1960x1897px:
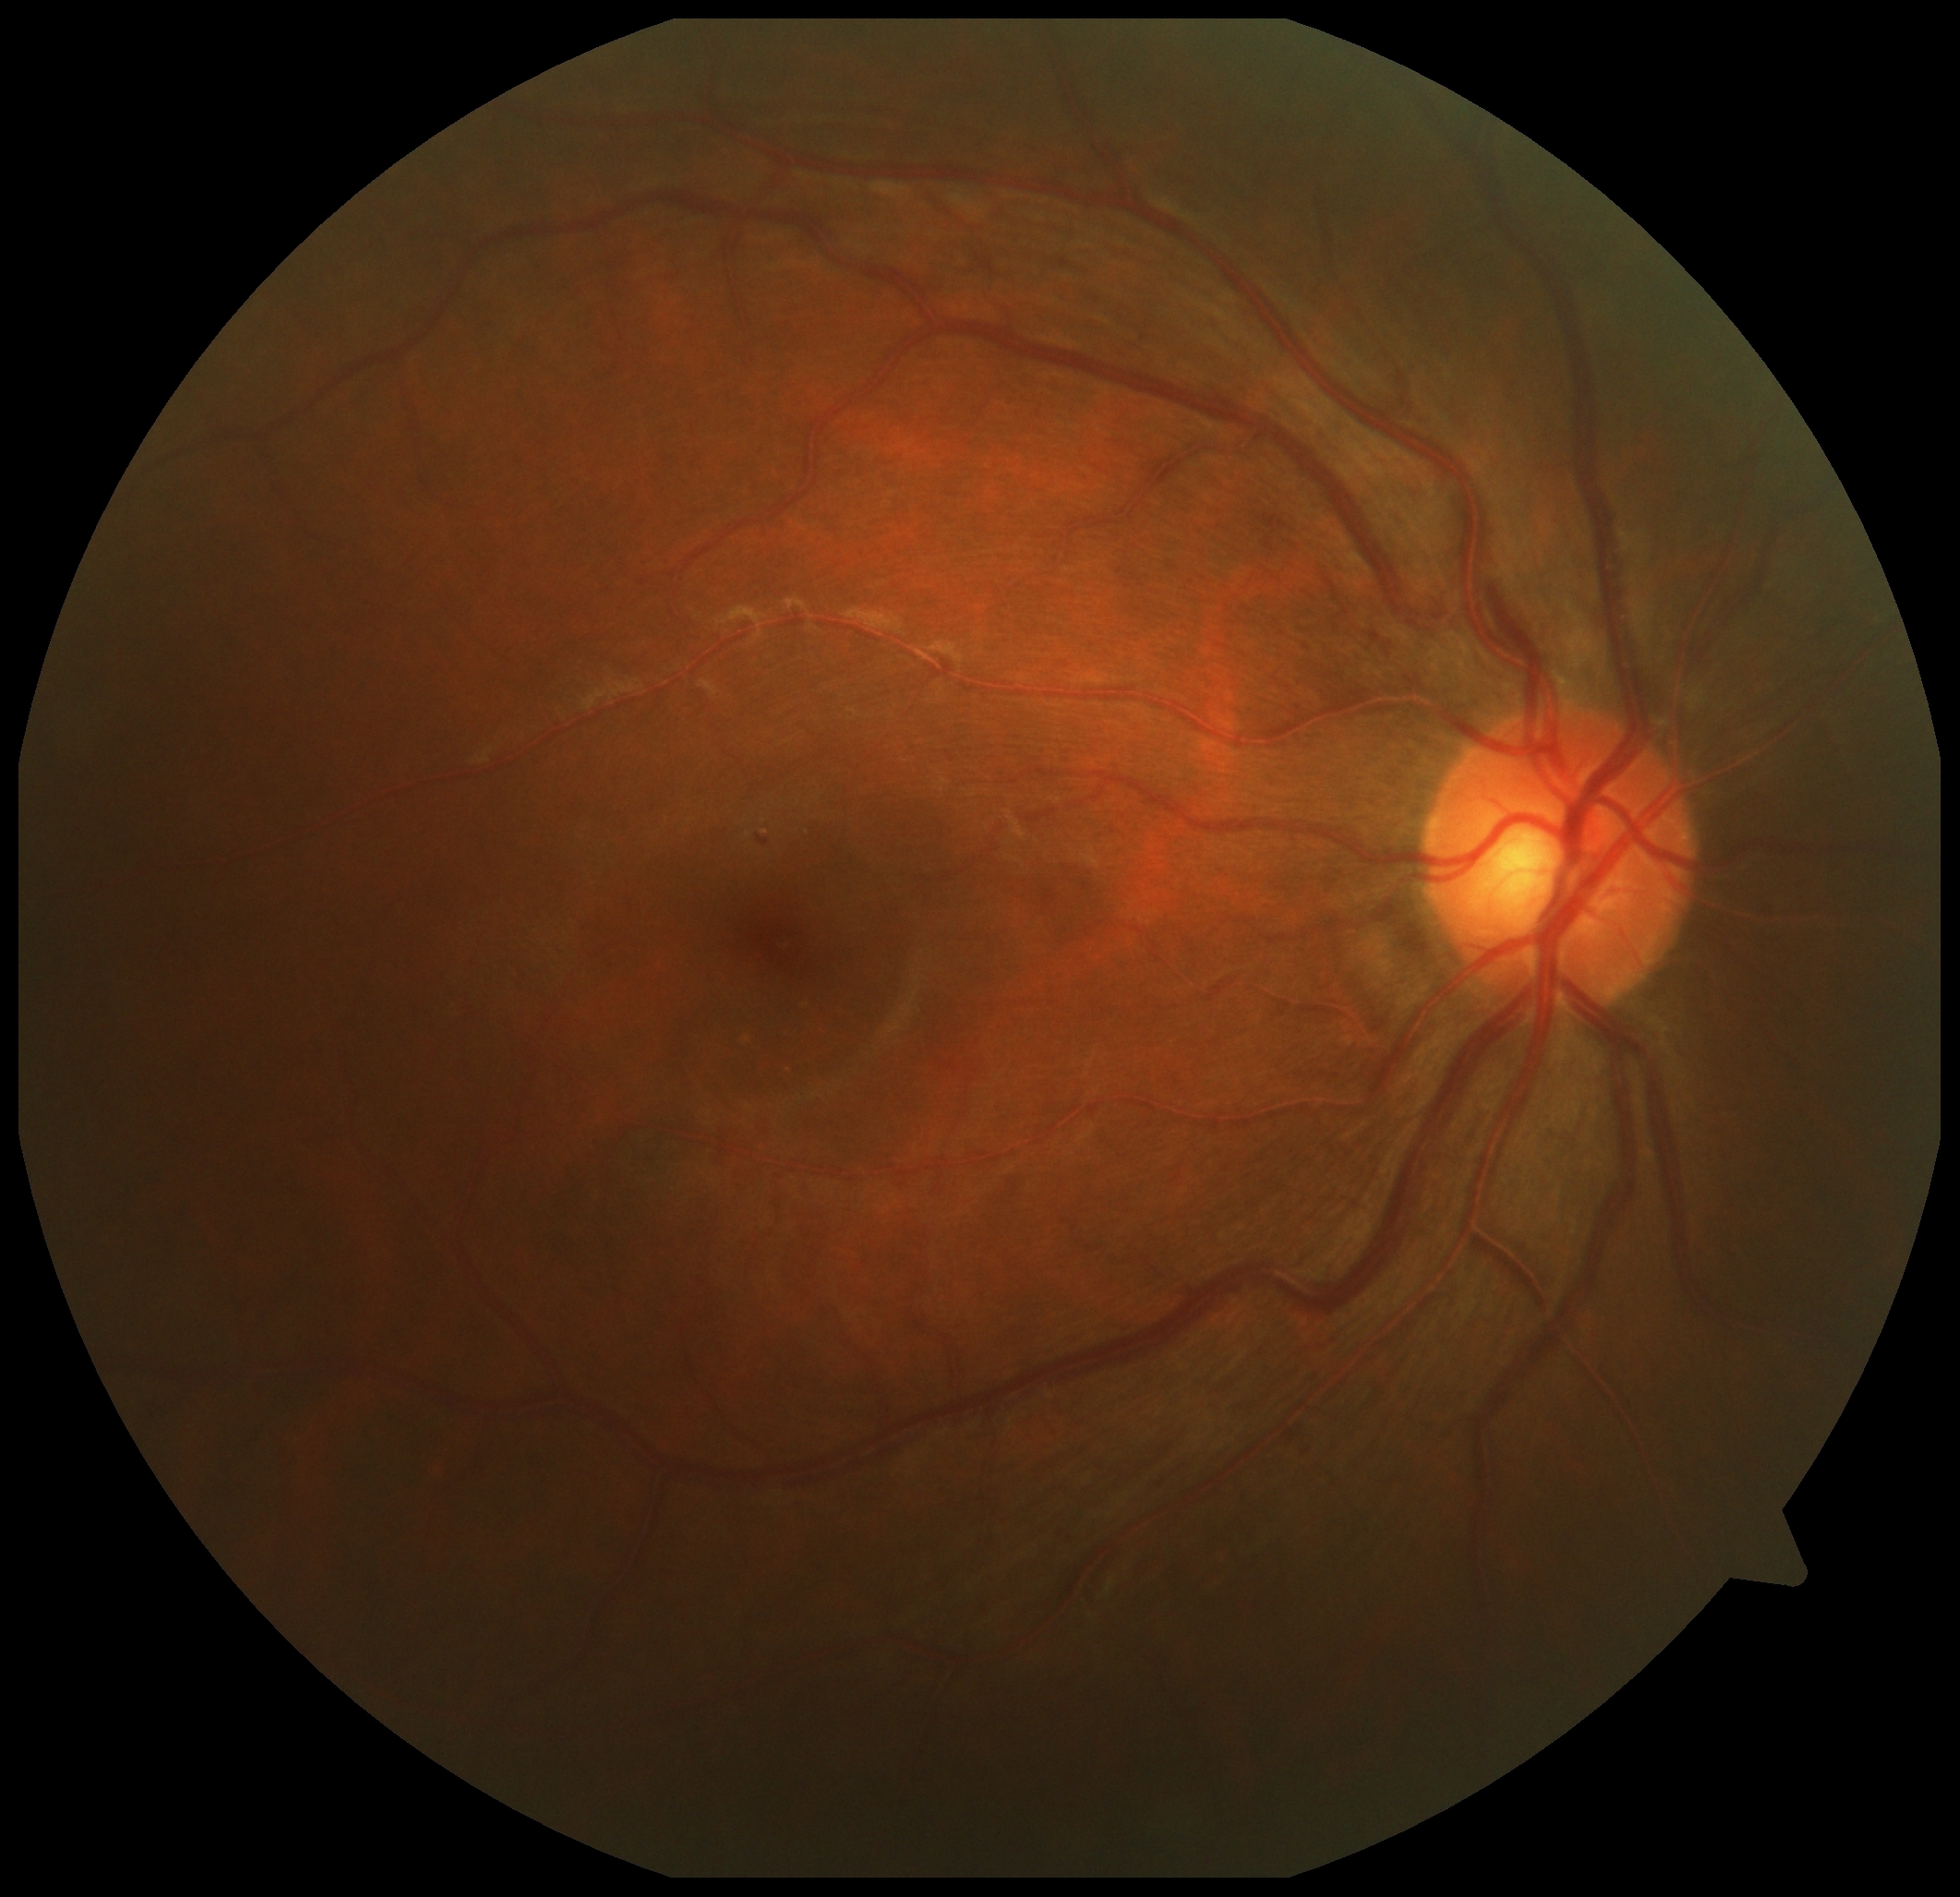 DR is grade 2 (moderate NPDR).